45° FOV. CFP:
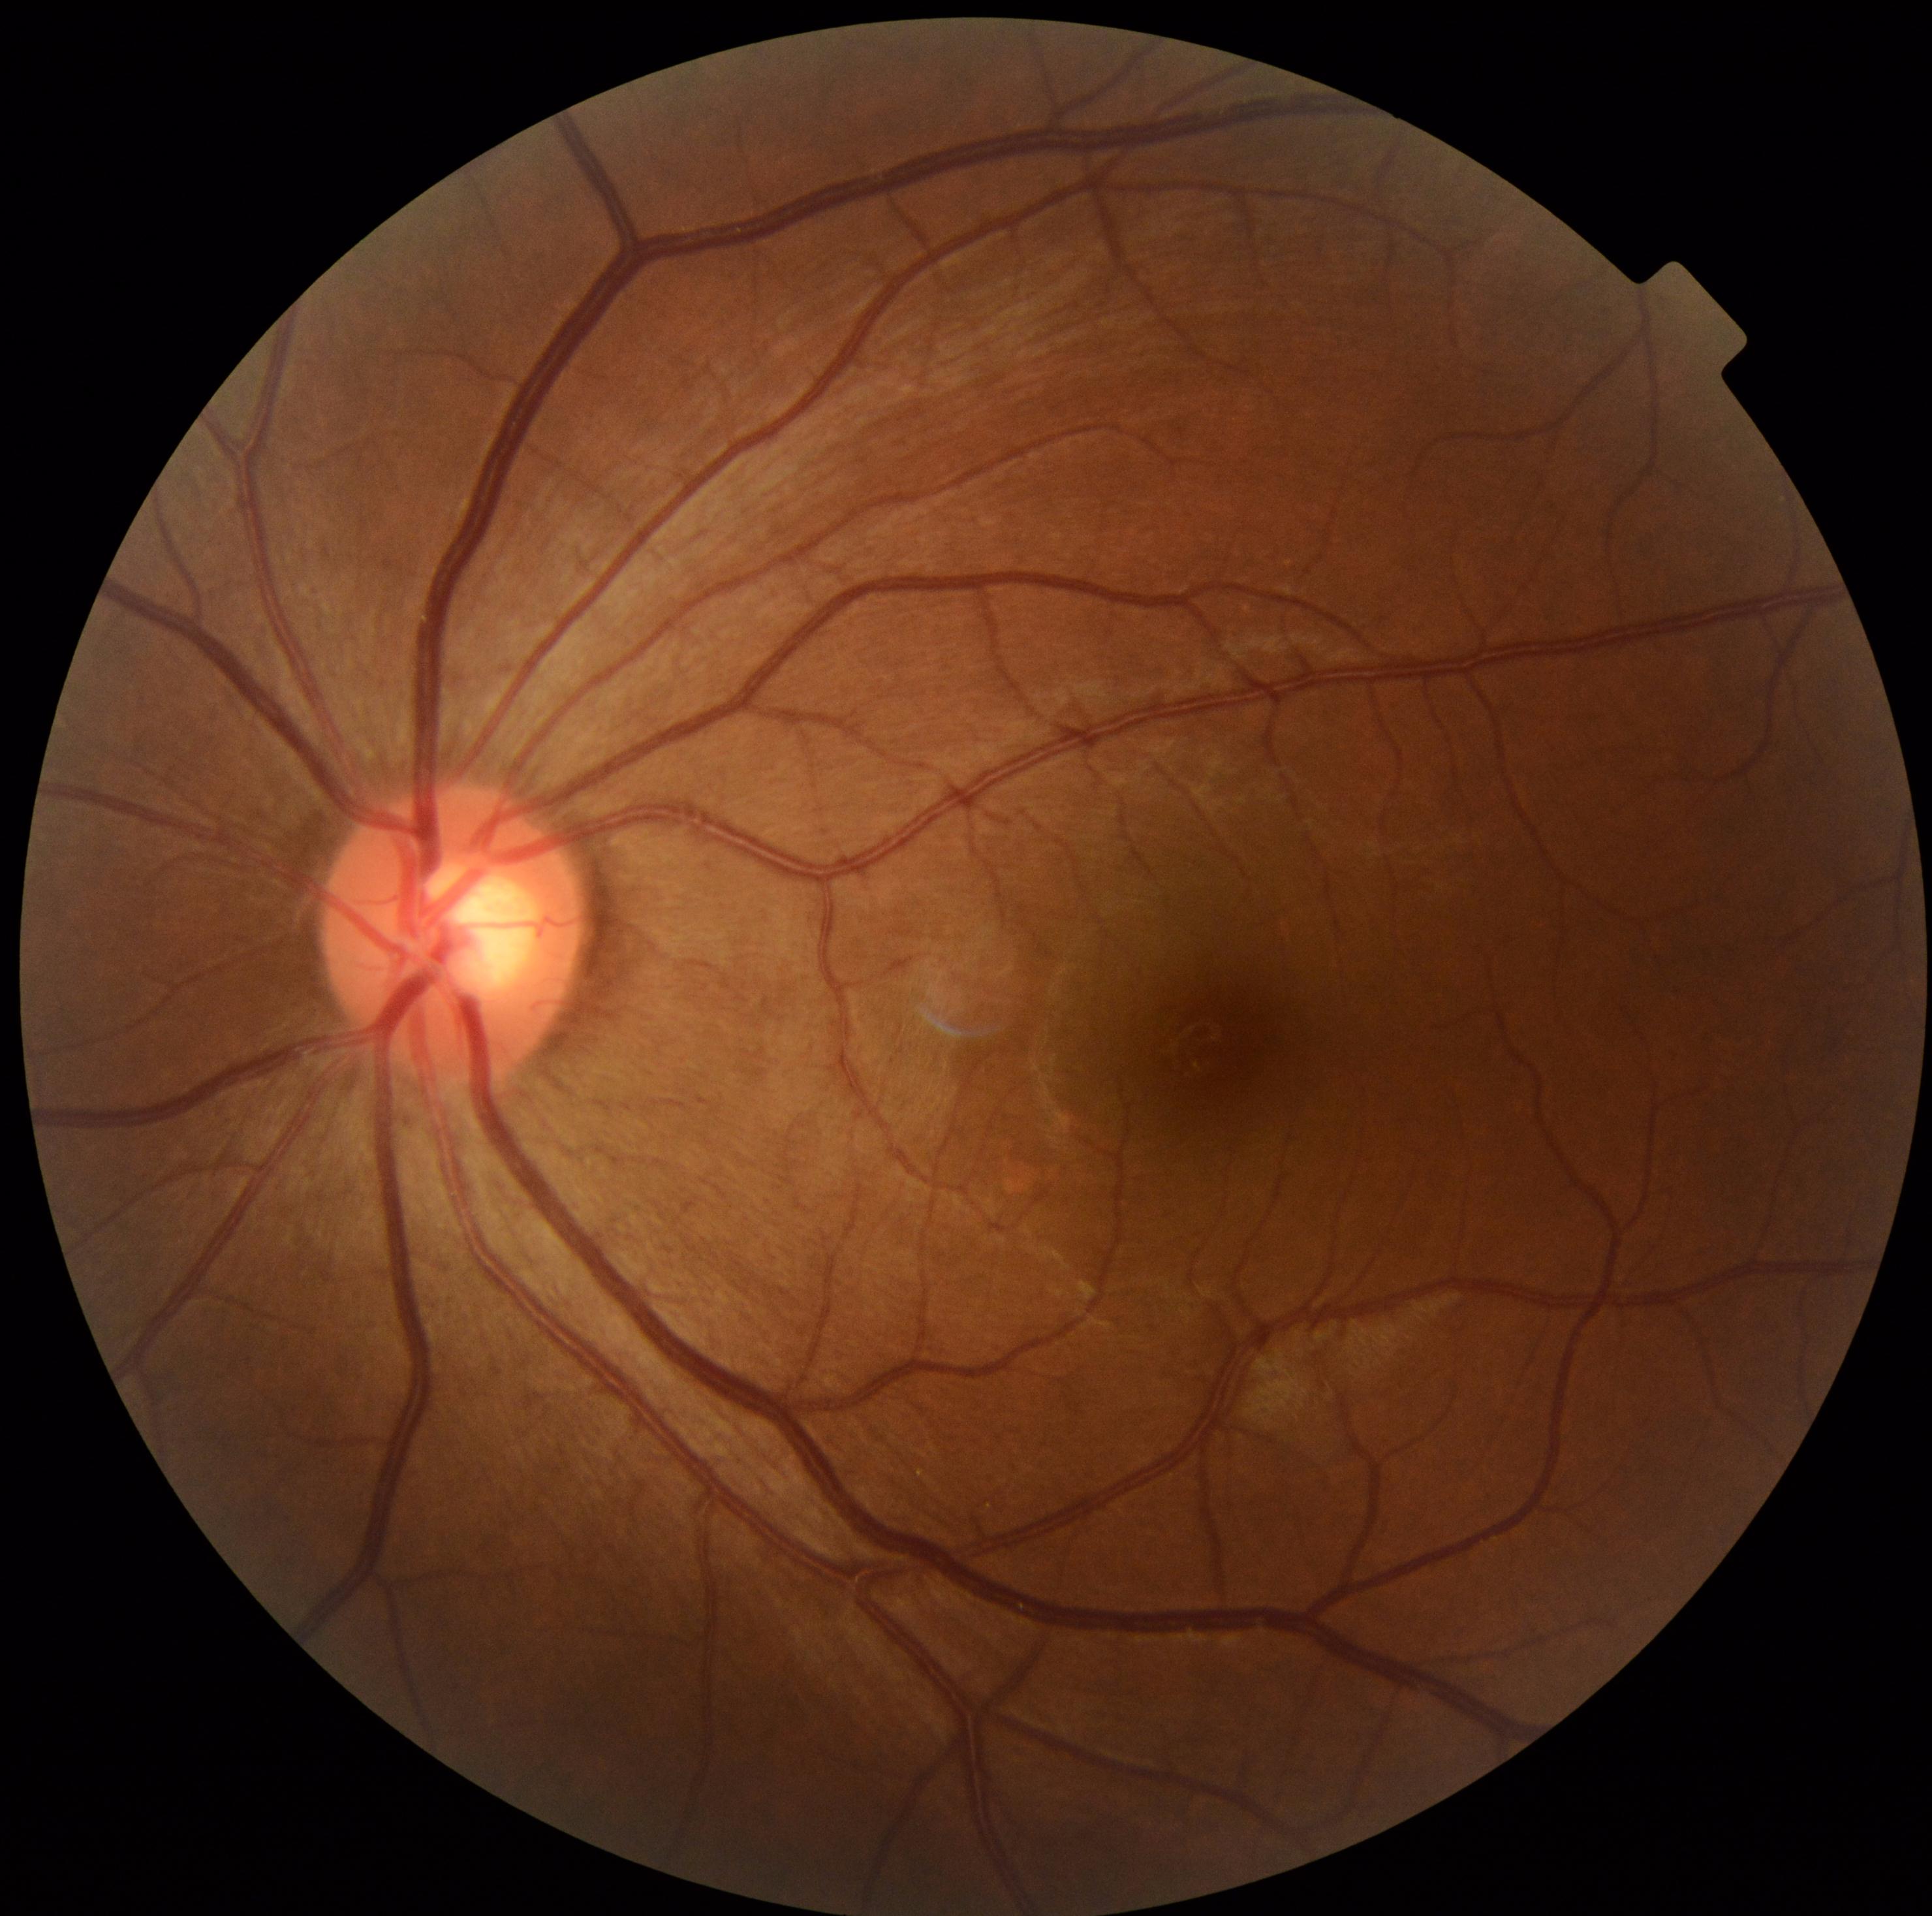 DR impression = no signs of DR | DR grade = 0.